45° field of view · image size 2212x1659: 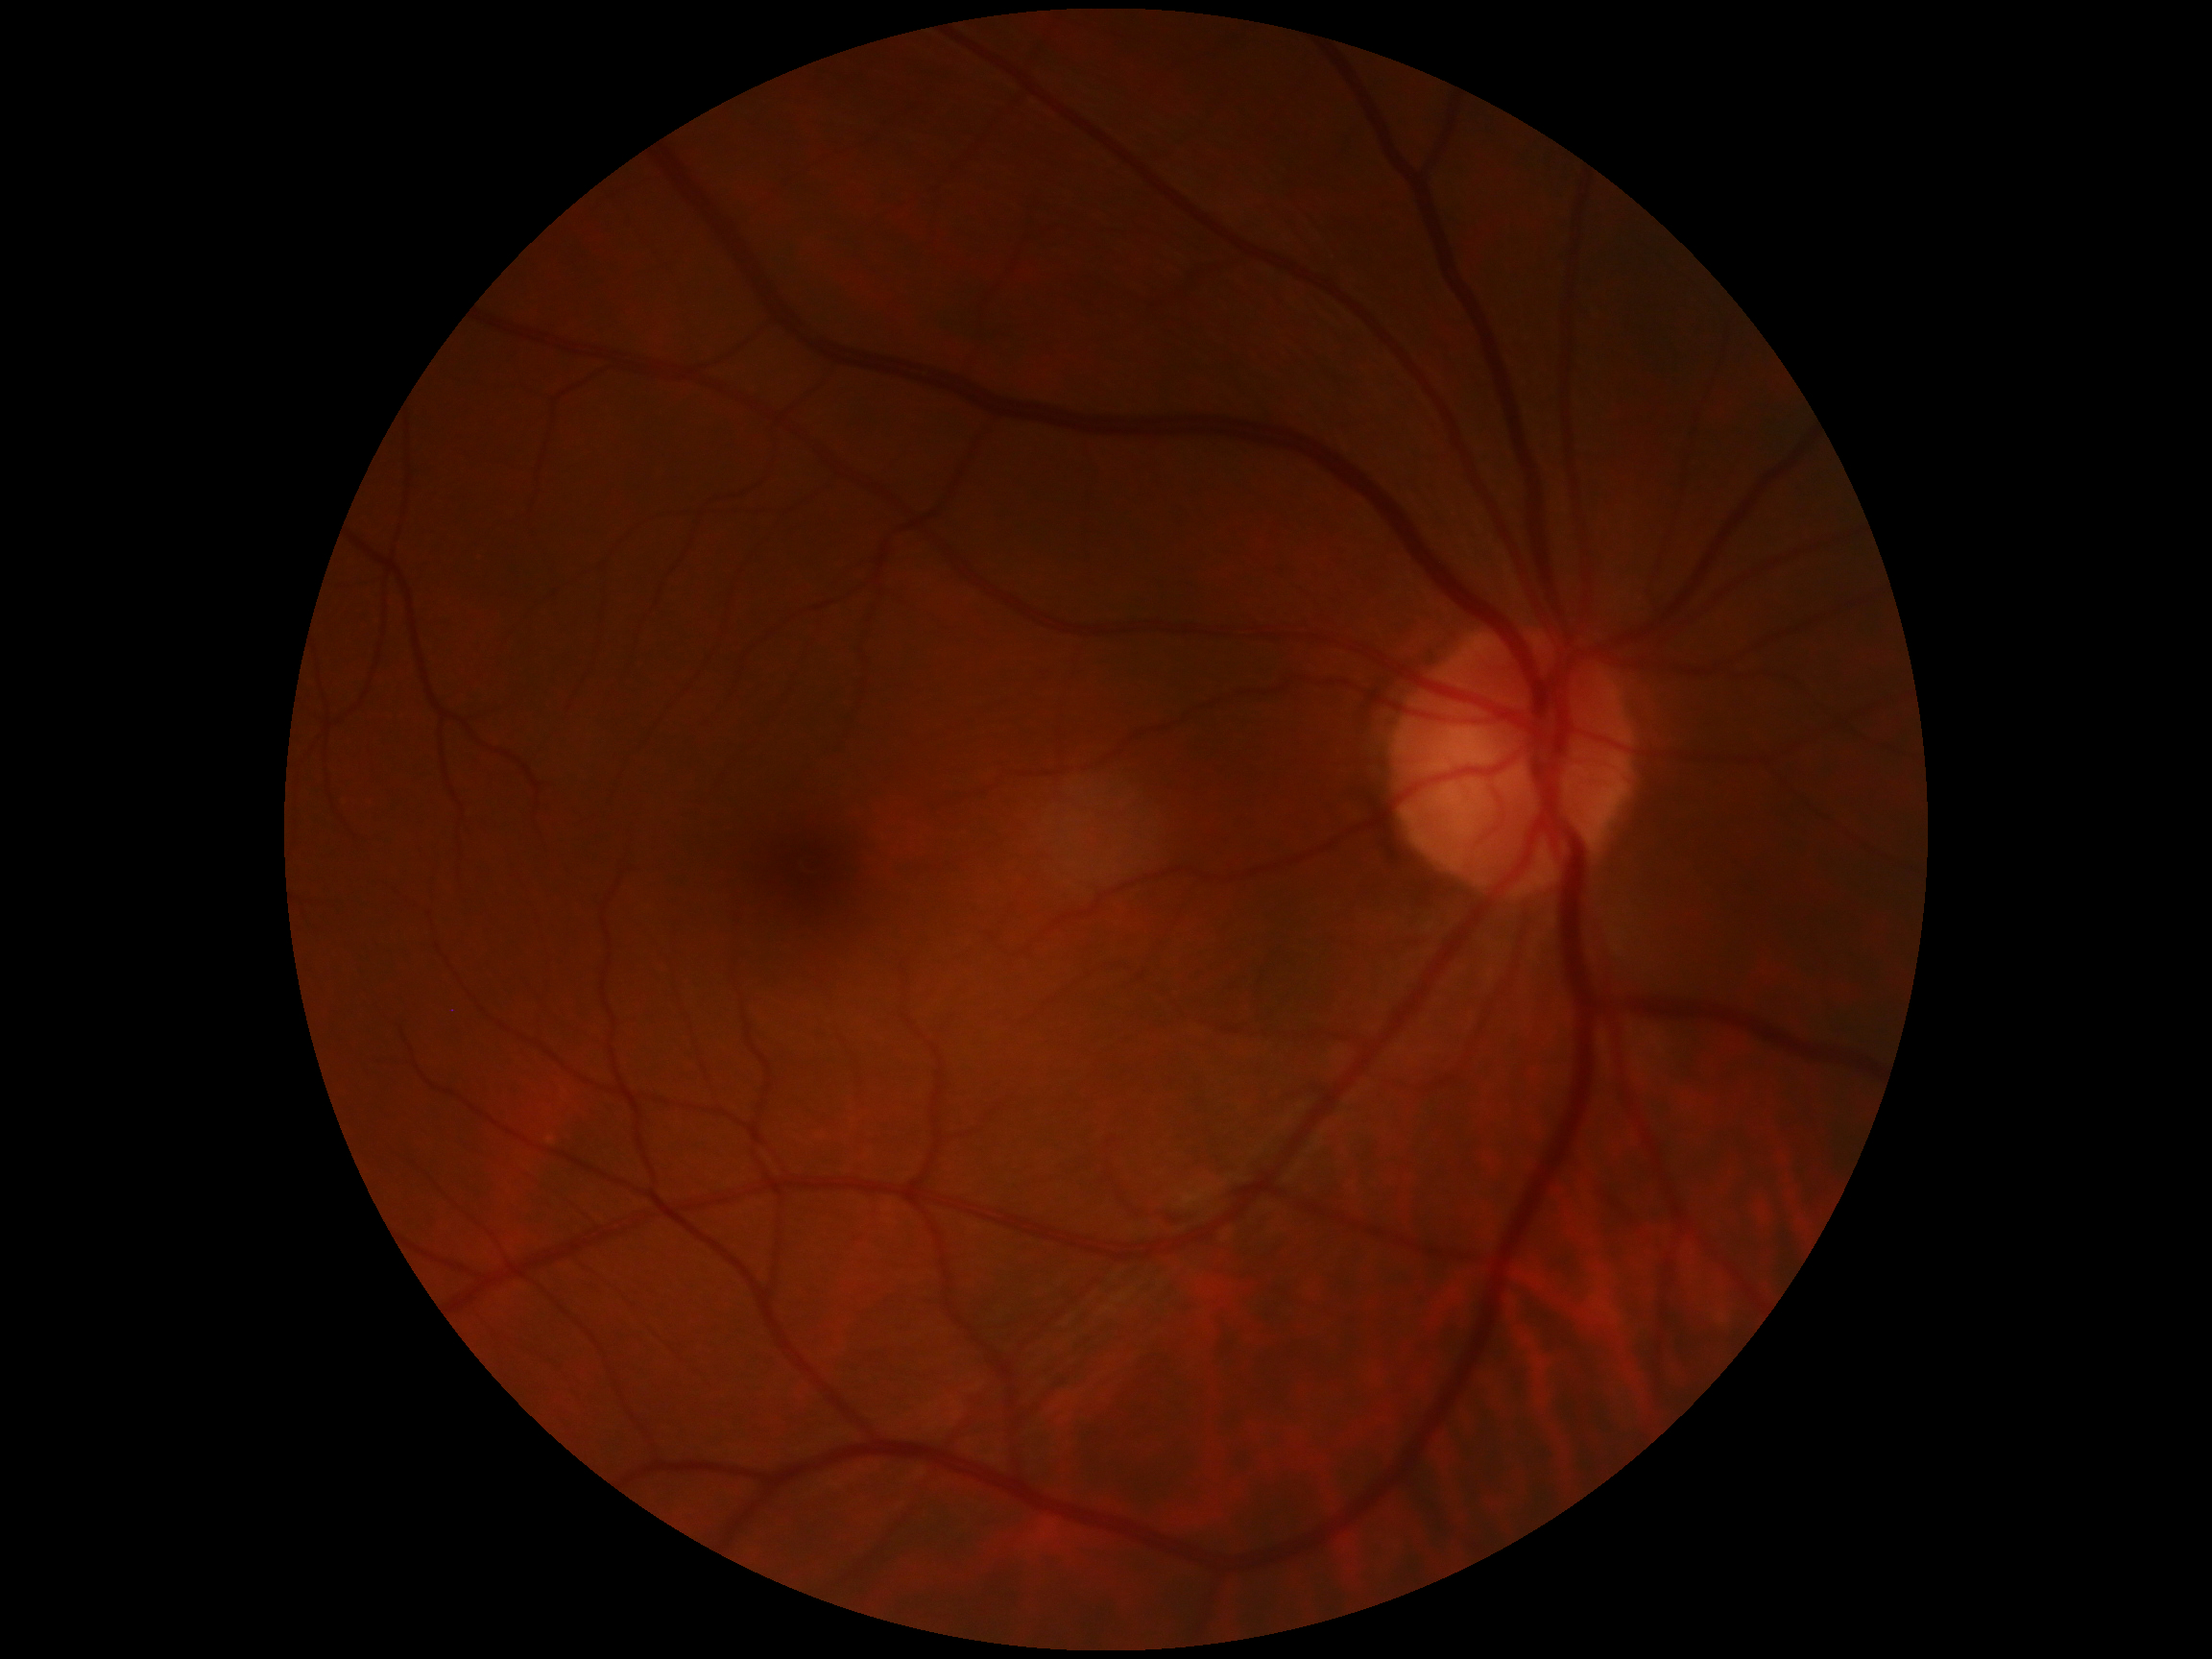 Diabetic retinopathy grade is 0 (no apparent retinopathy).